Color fundus image.
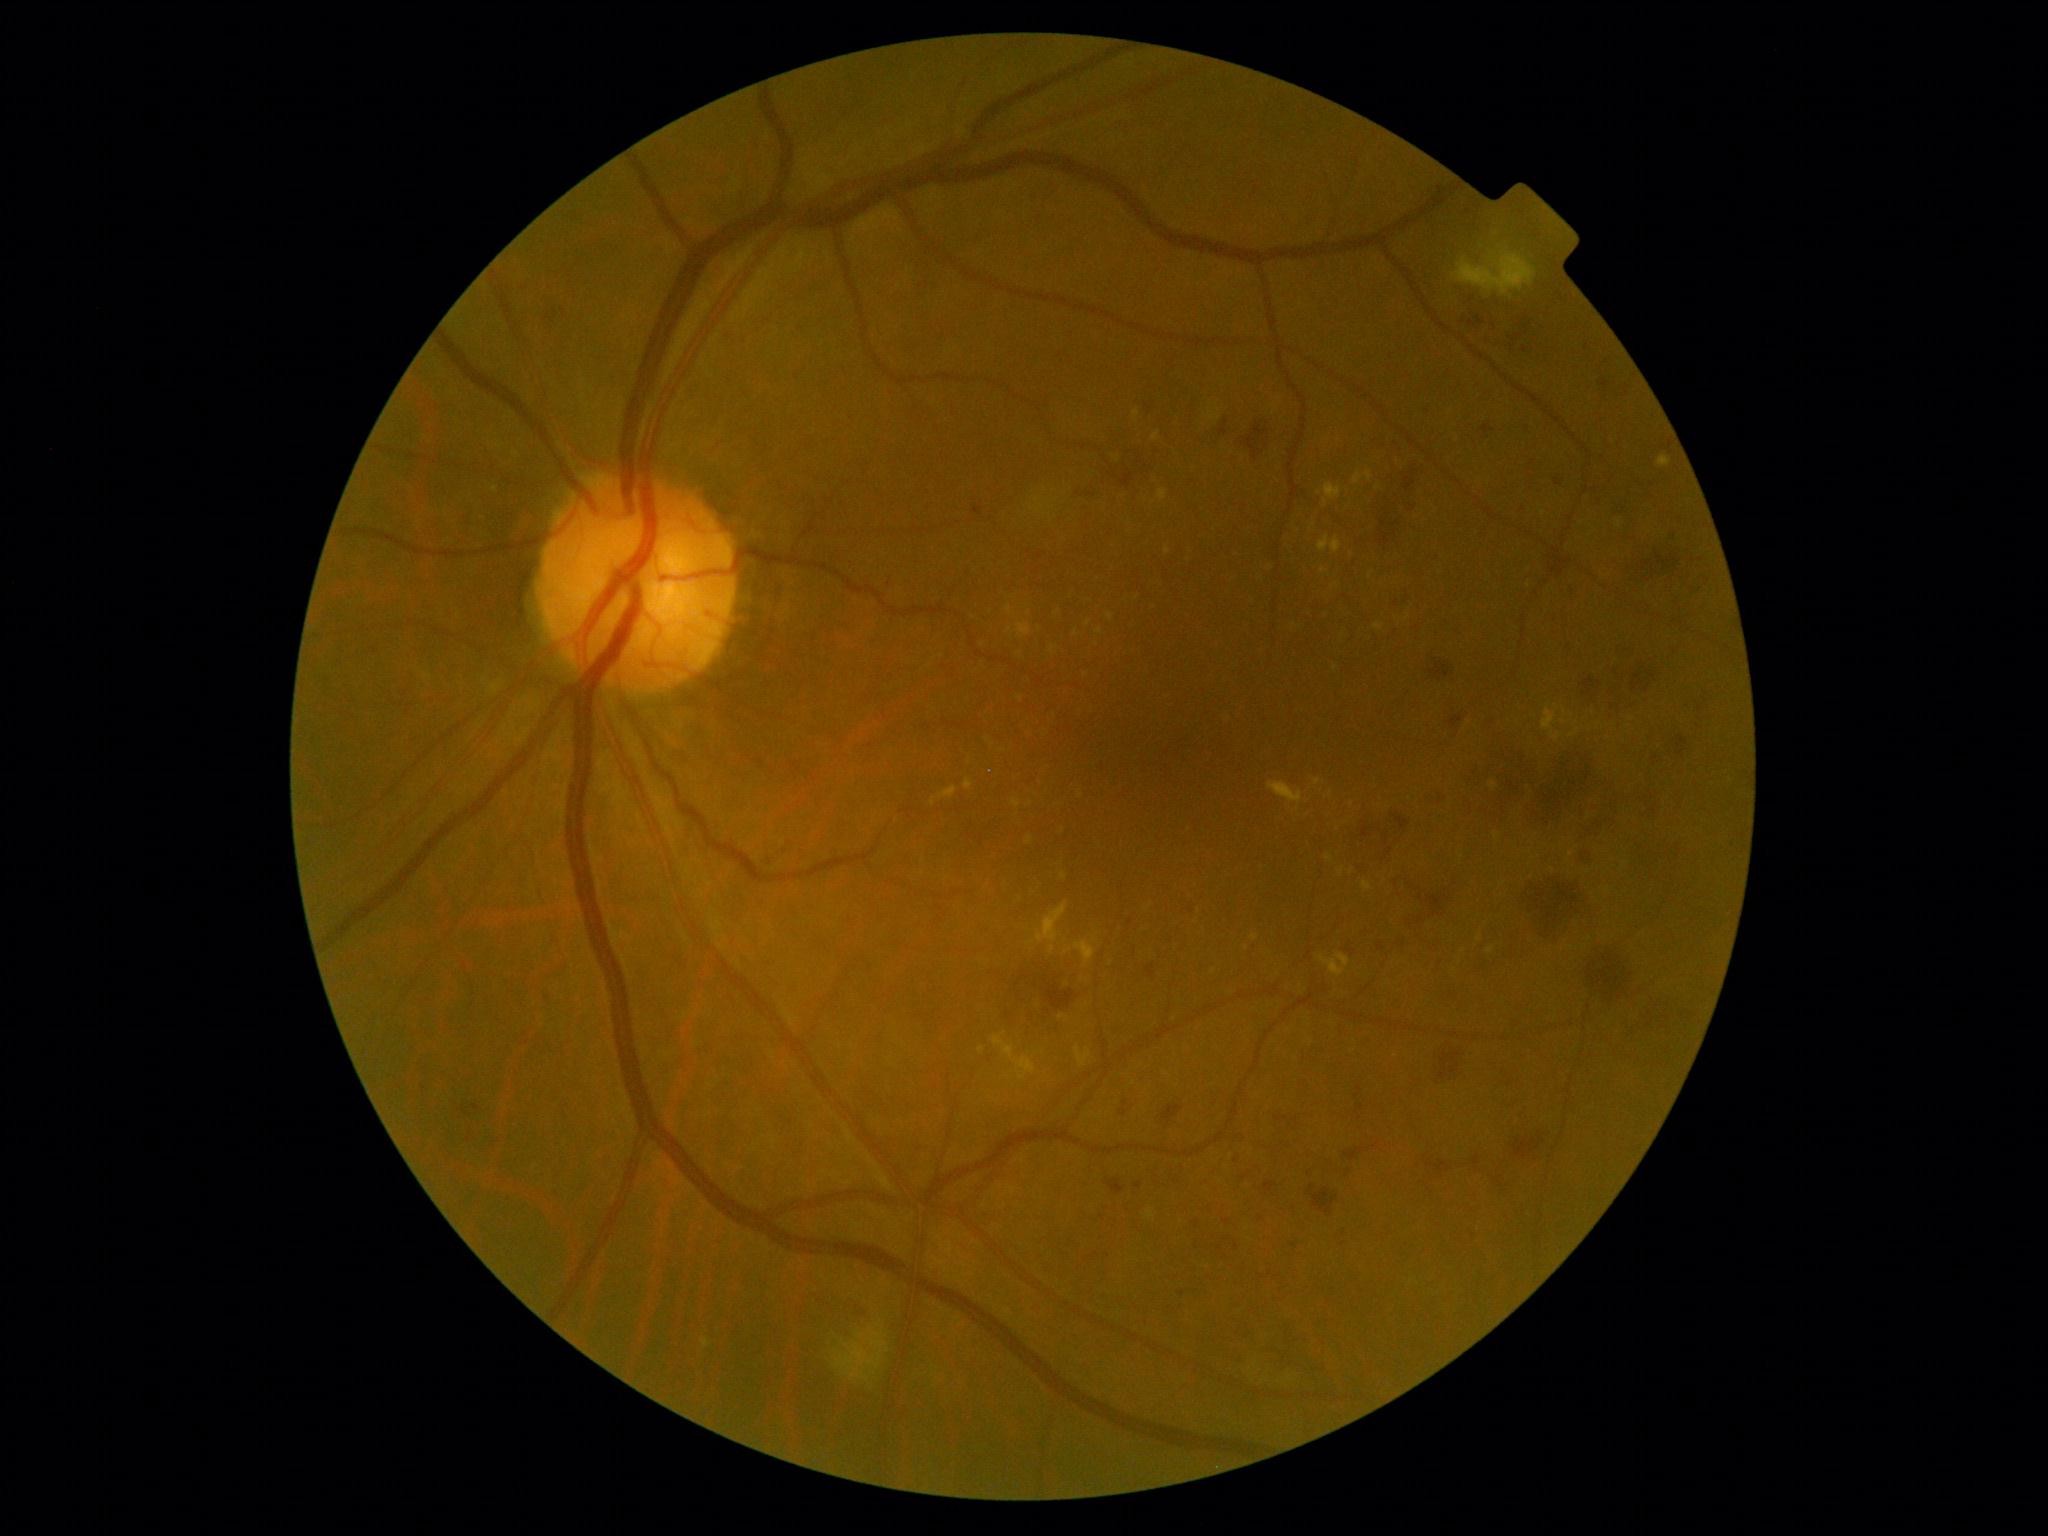
{"dr_grade": "2/4"}